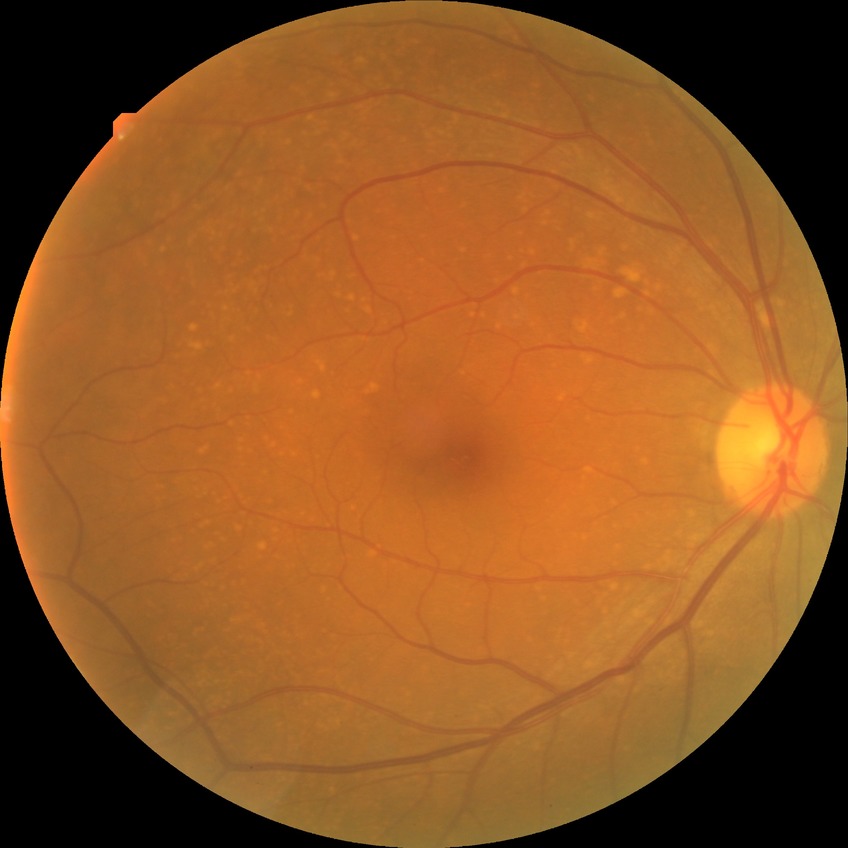 modified Davis classification=no diabetic retinopathy.